Wide-field fundus image from infant ROP screening · Clarity RetCam 3, 130° FOV: 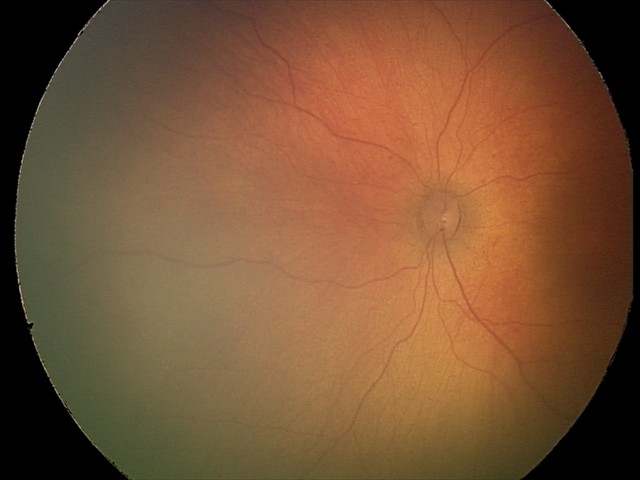
Examination with physiological retinal findings.